Fundus photo
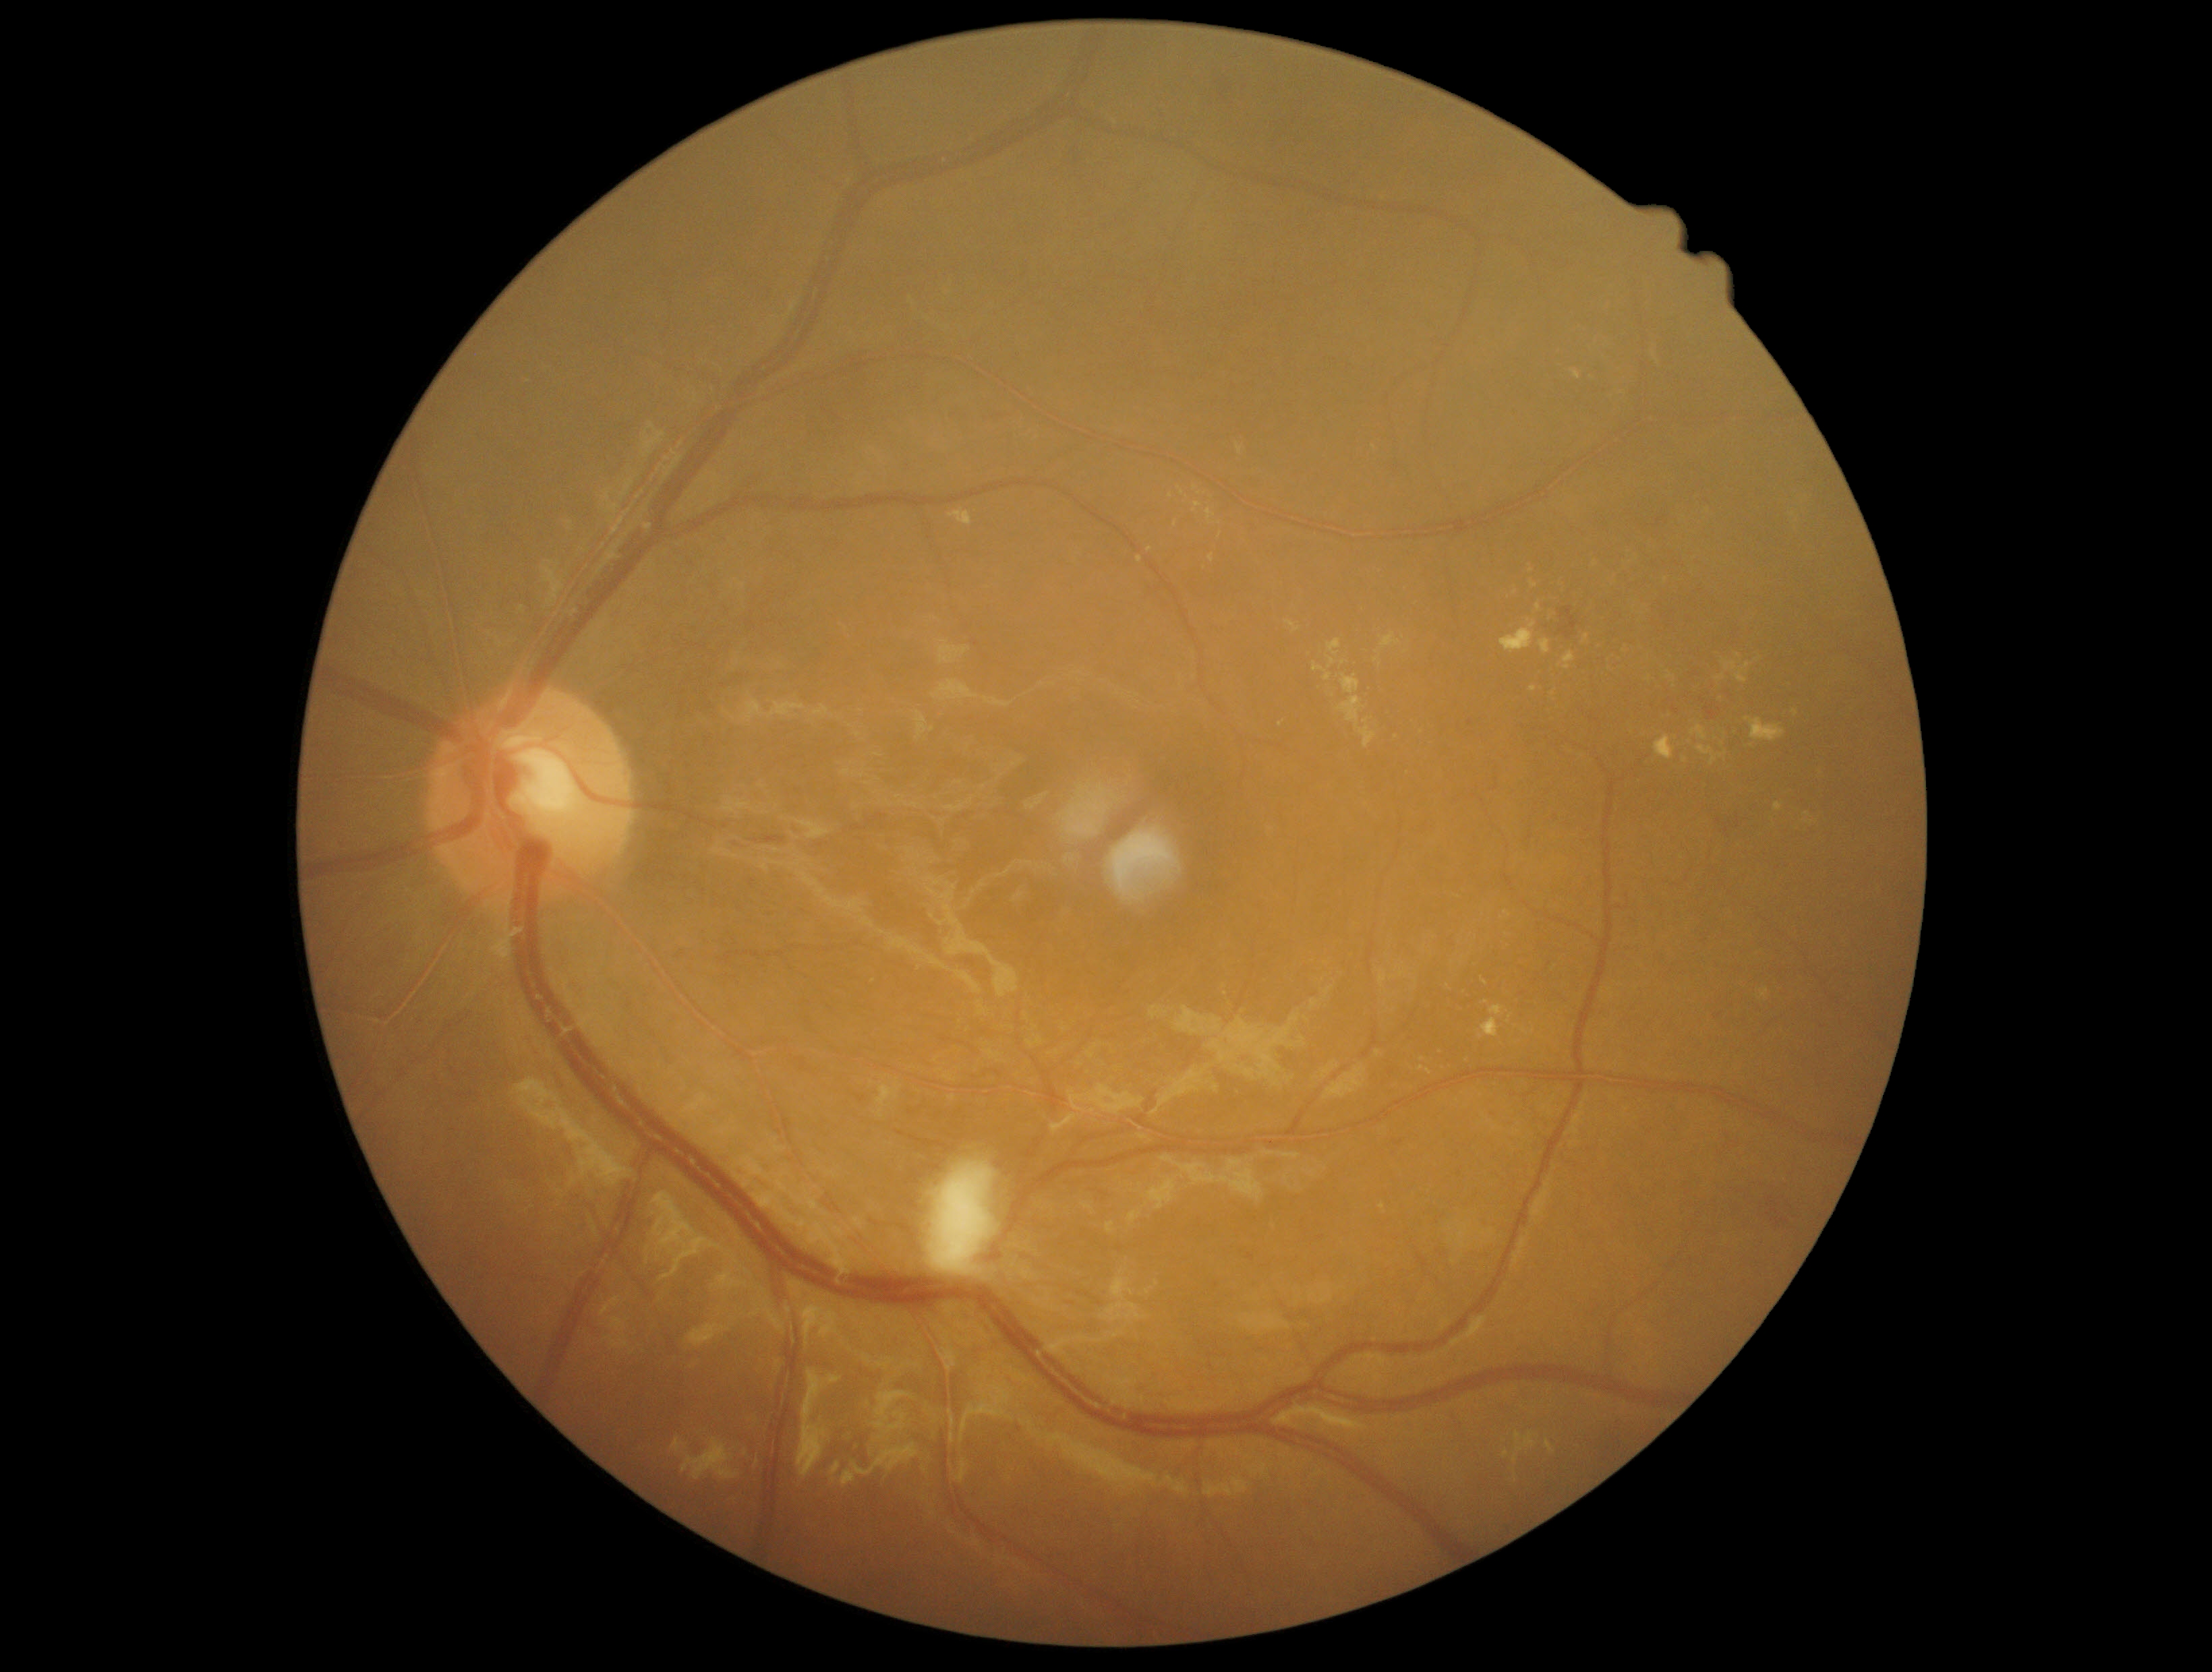
DR grade: moderate NPDR (2).